Acquired with a NIDEK AFC-230 · nonmydriatic — 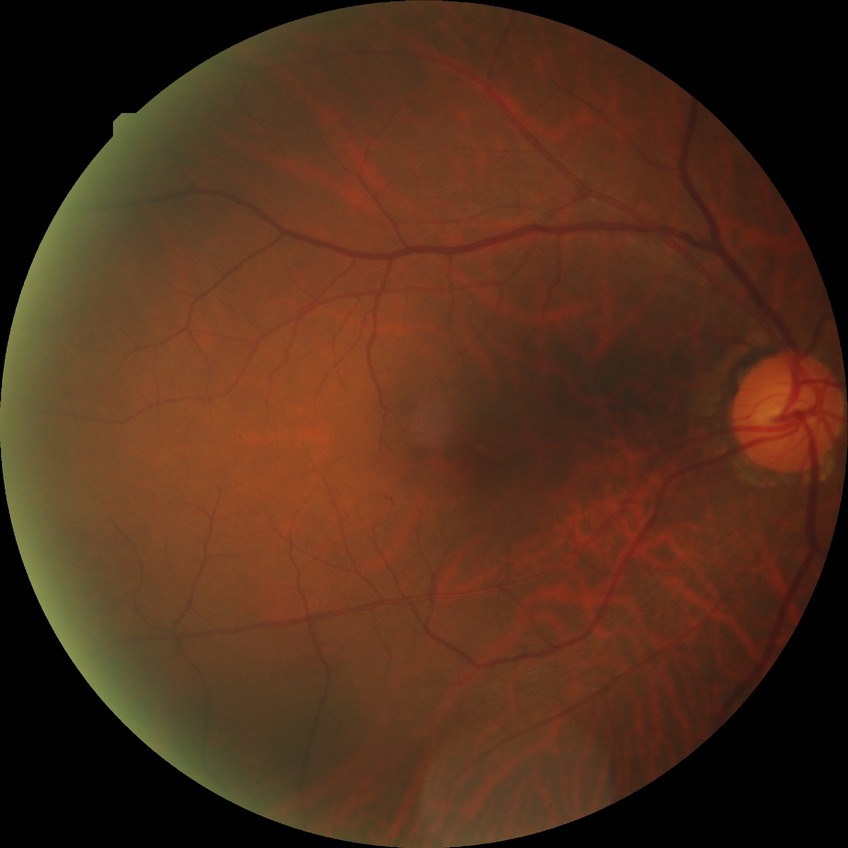

Diabetic retinopathy (DR) is NDR (no diabetic retinopathy).